Camera: Natus RetCam Envision (130° FOV); pediatric retinal photograph (wide-field):
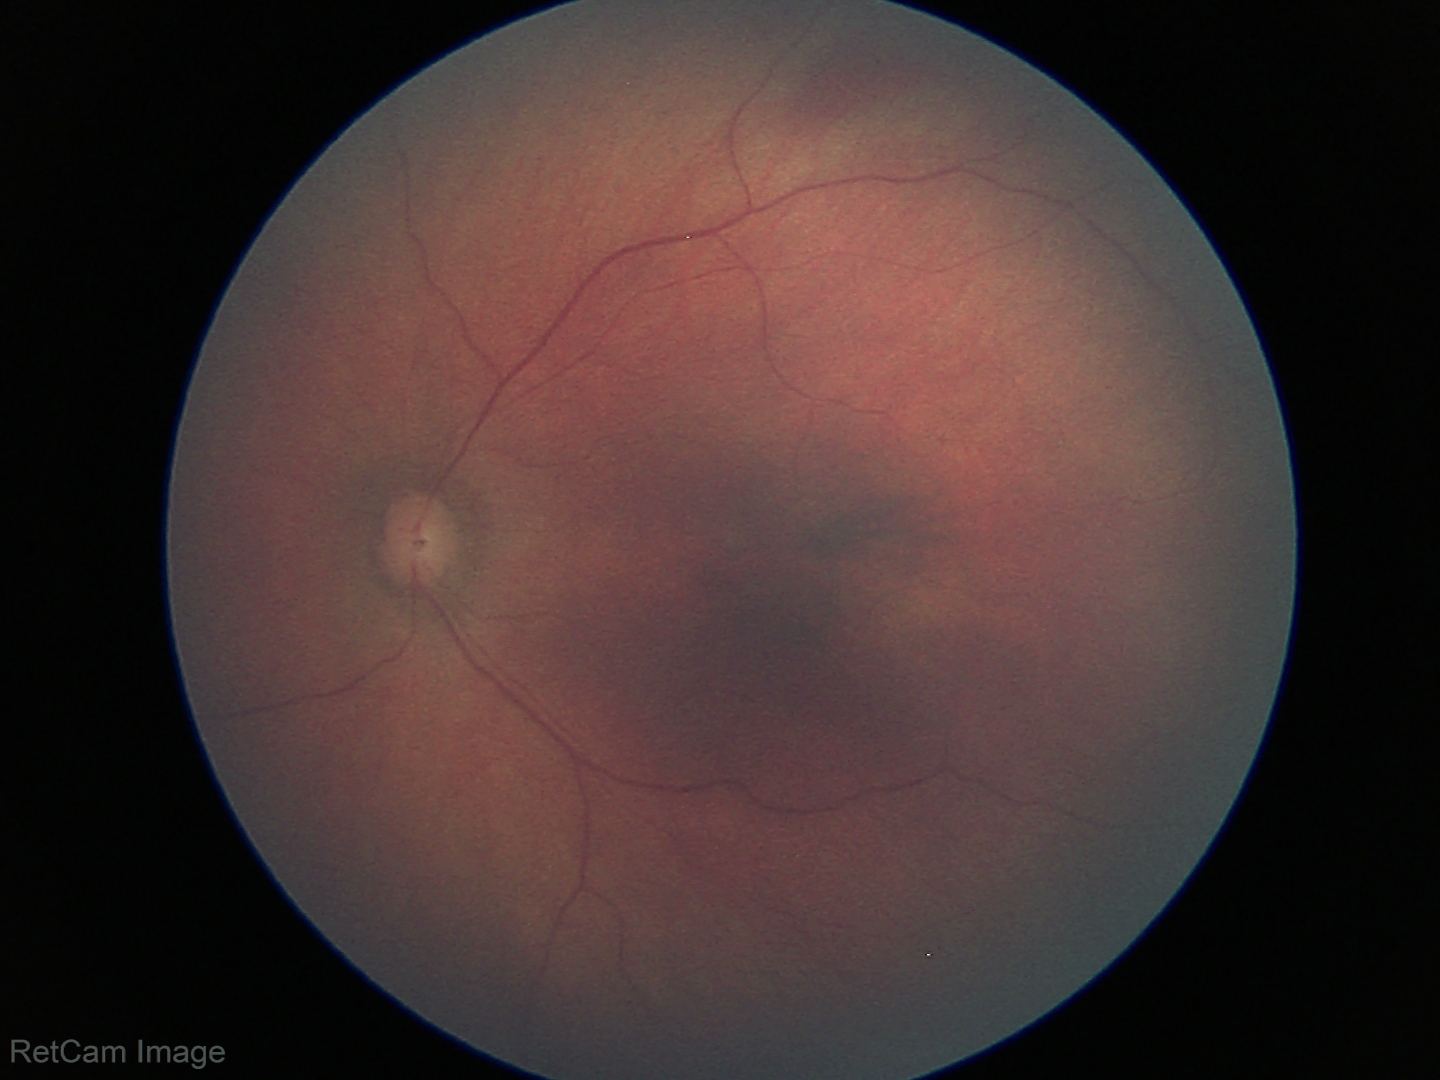
Screening examination with no abnormal retinal findings.